Acquired on the Phoenix ICON. 1240x1240. Infant wide-field retinal image:
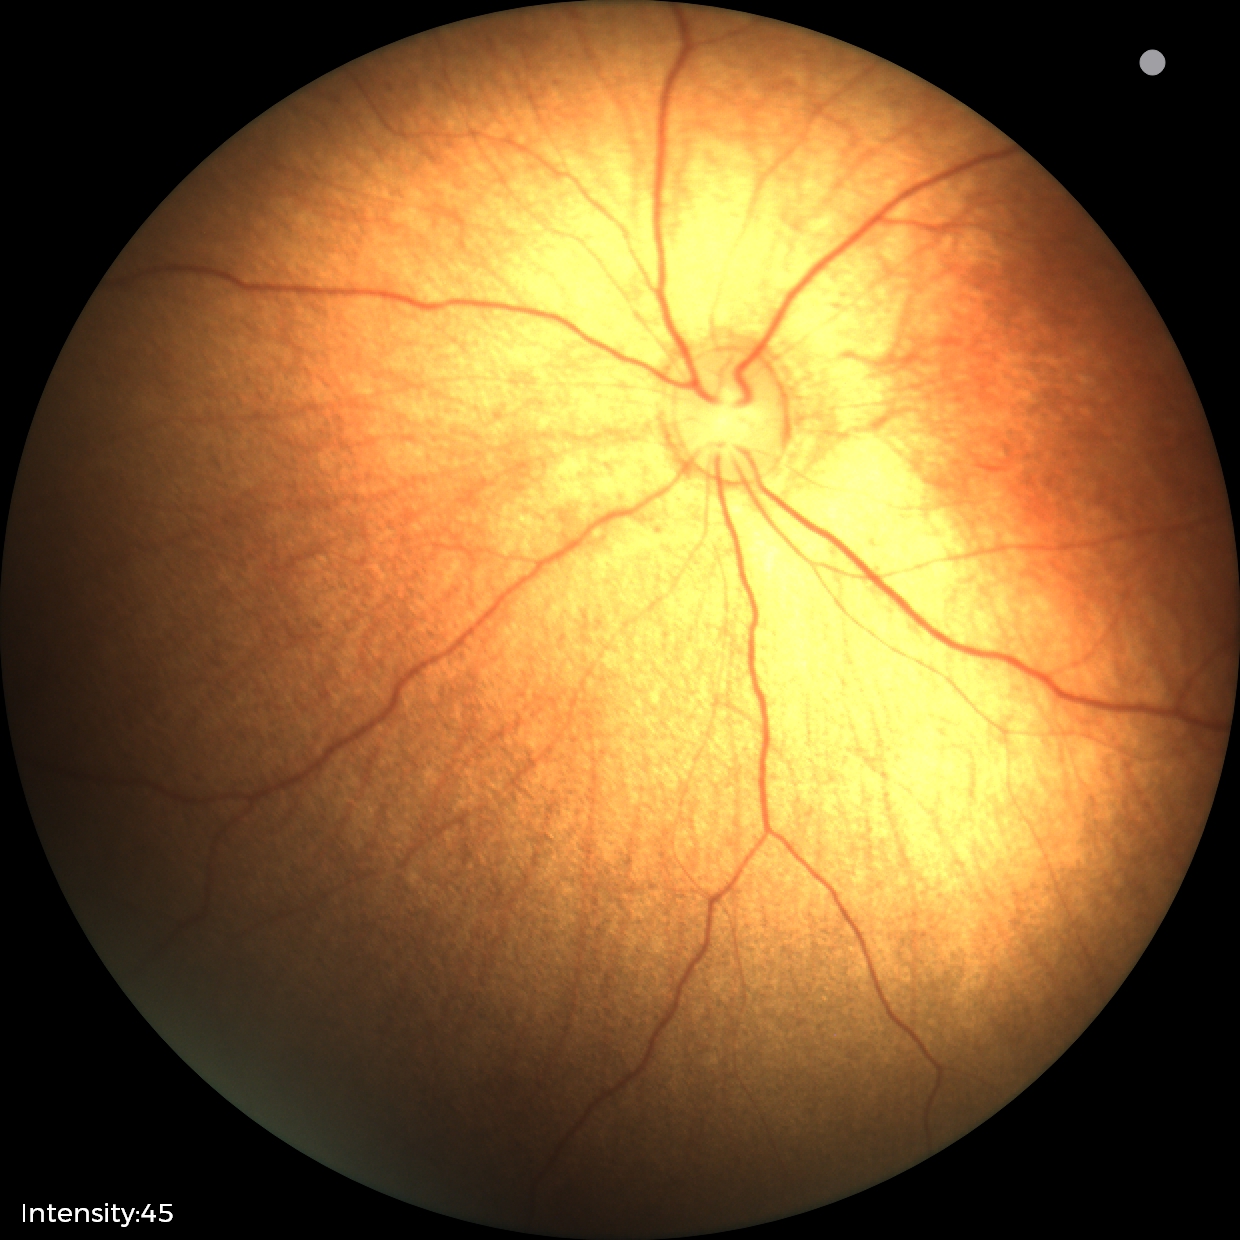 Screening diagnosis: normal fundus examination.